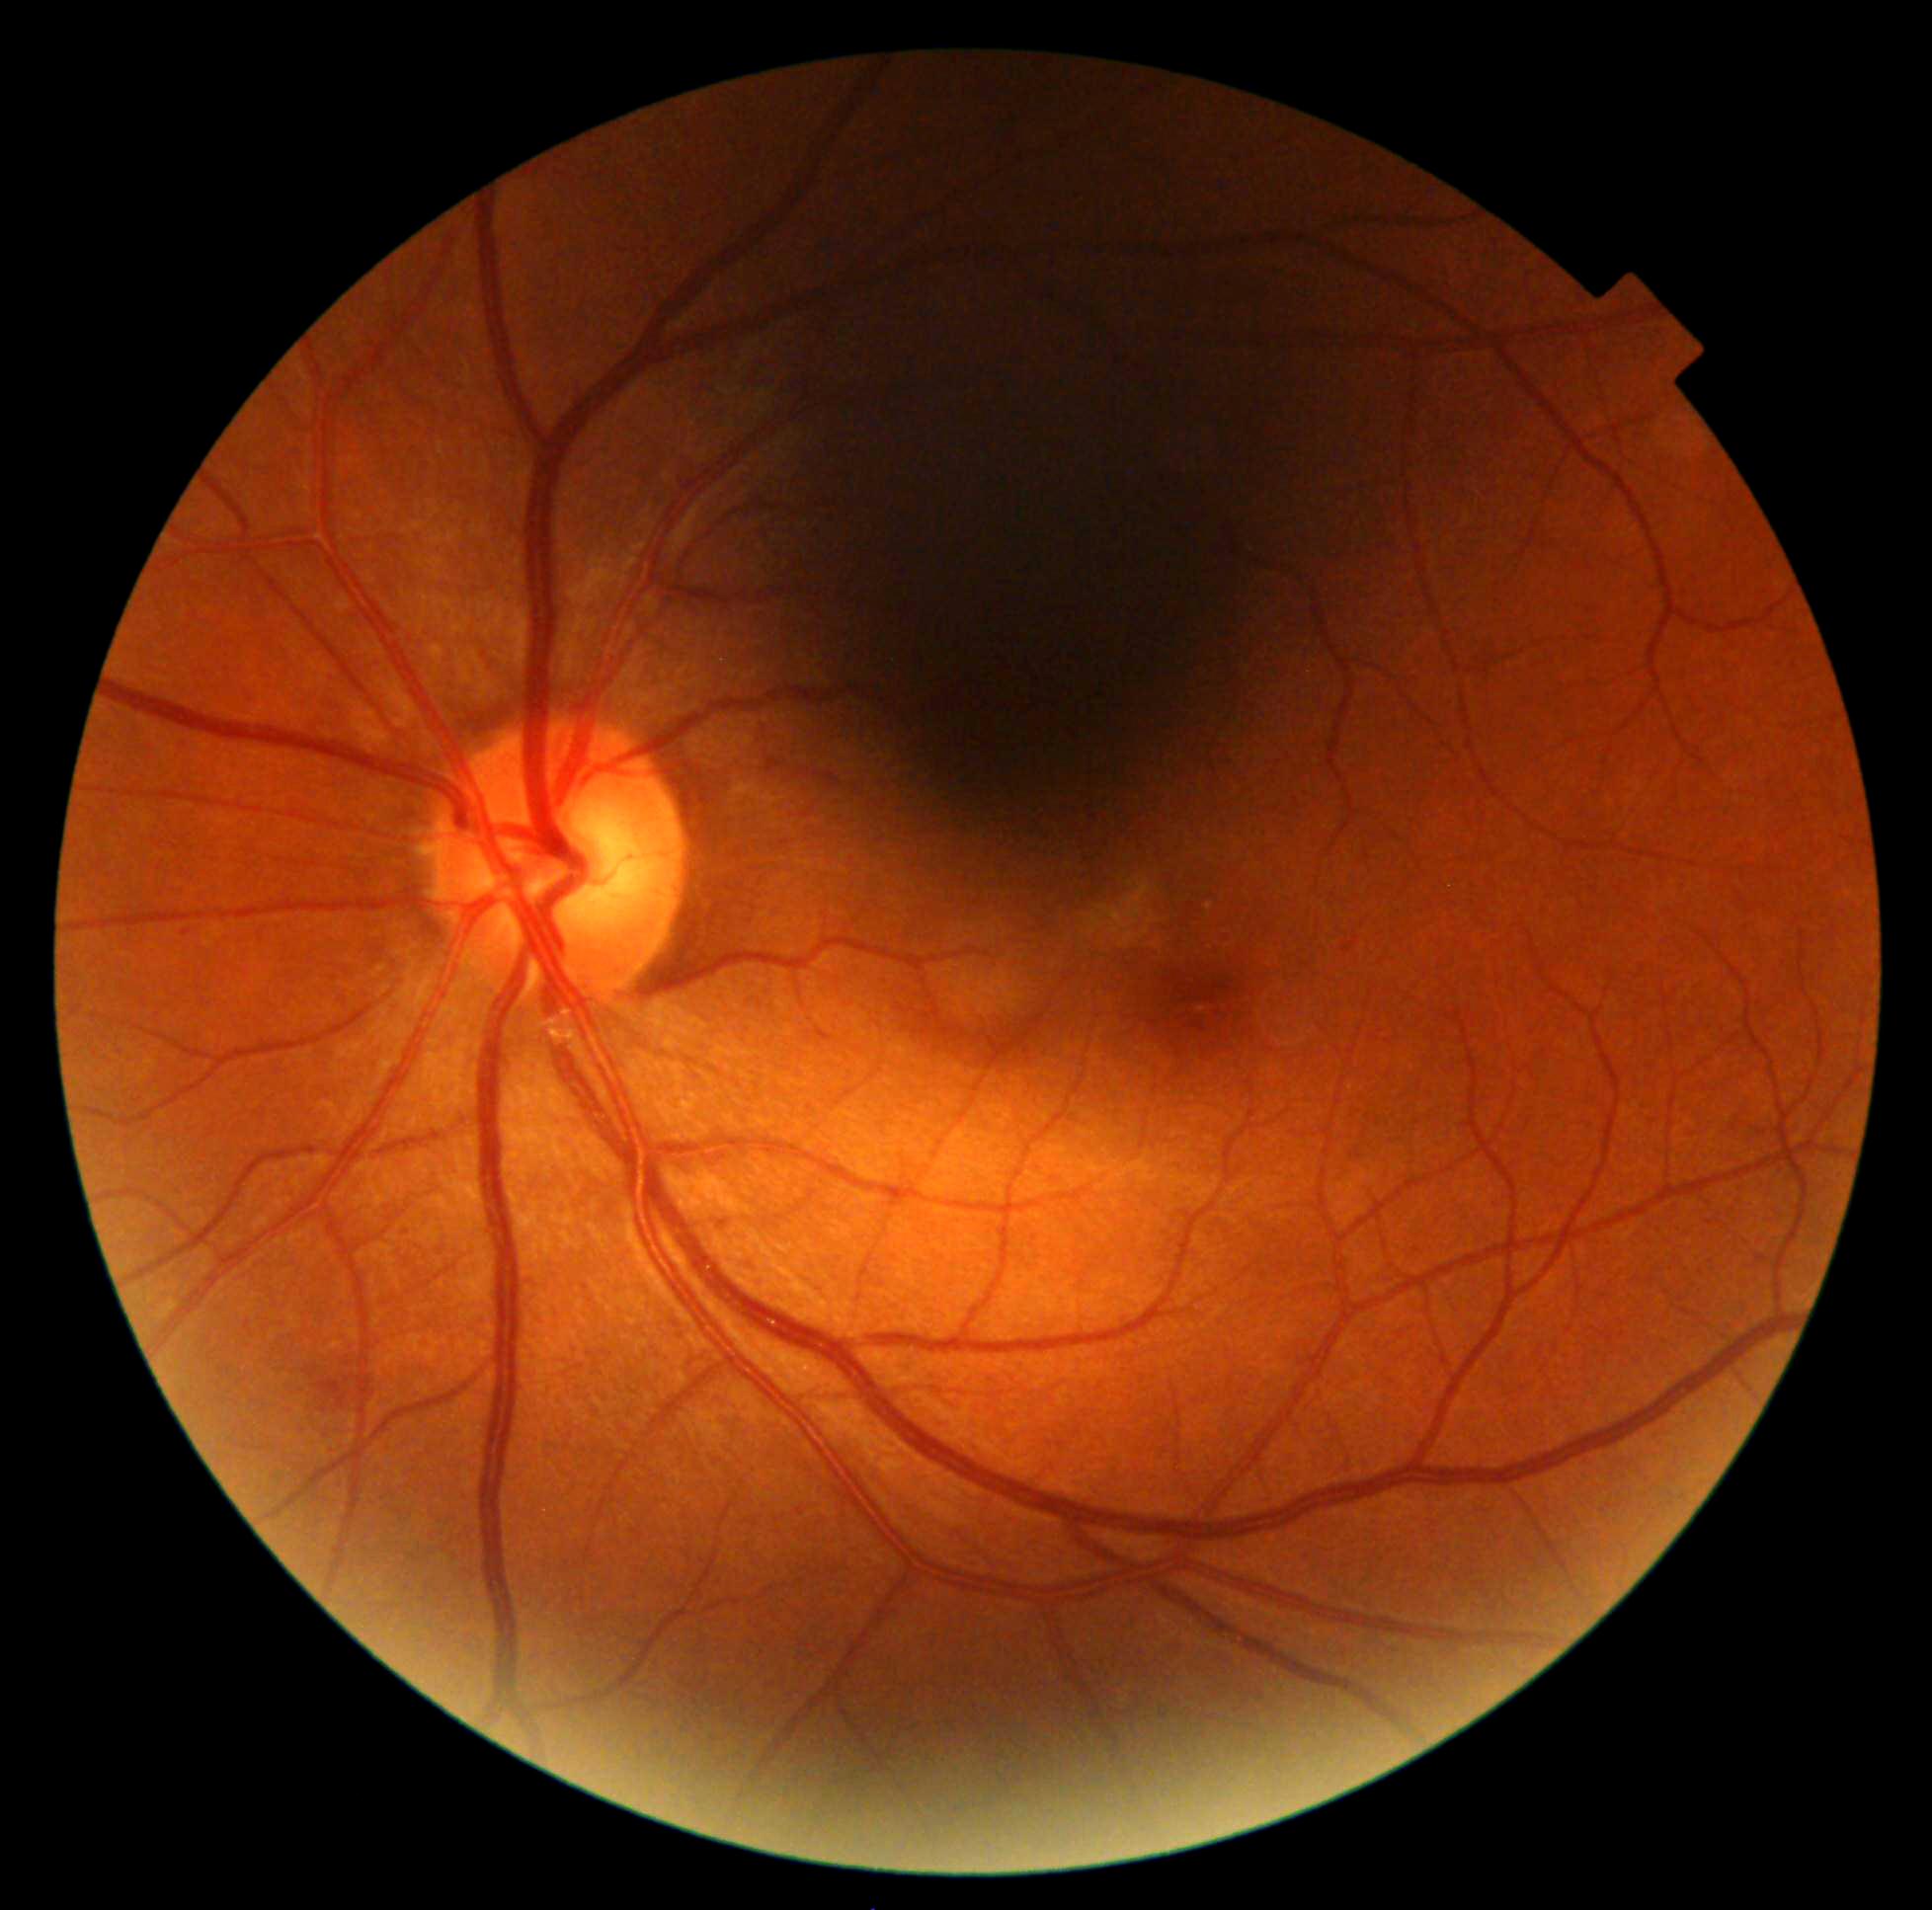

DR severity: moderate NPDR (grade 2).
Disease class: non-proliferative diabetic retinopathy.